FOV: 45 degrees. Color fundus image. 1380x1382px
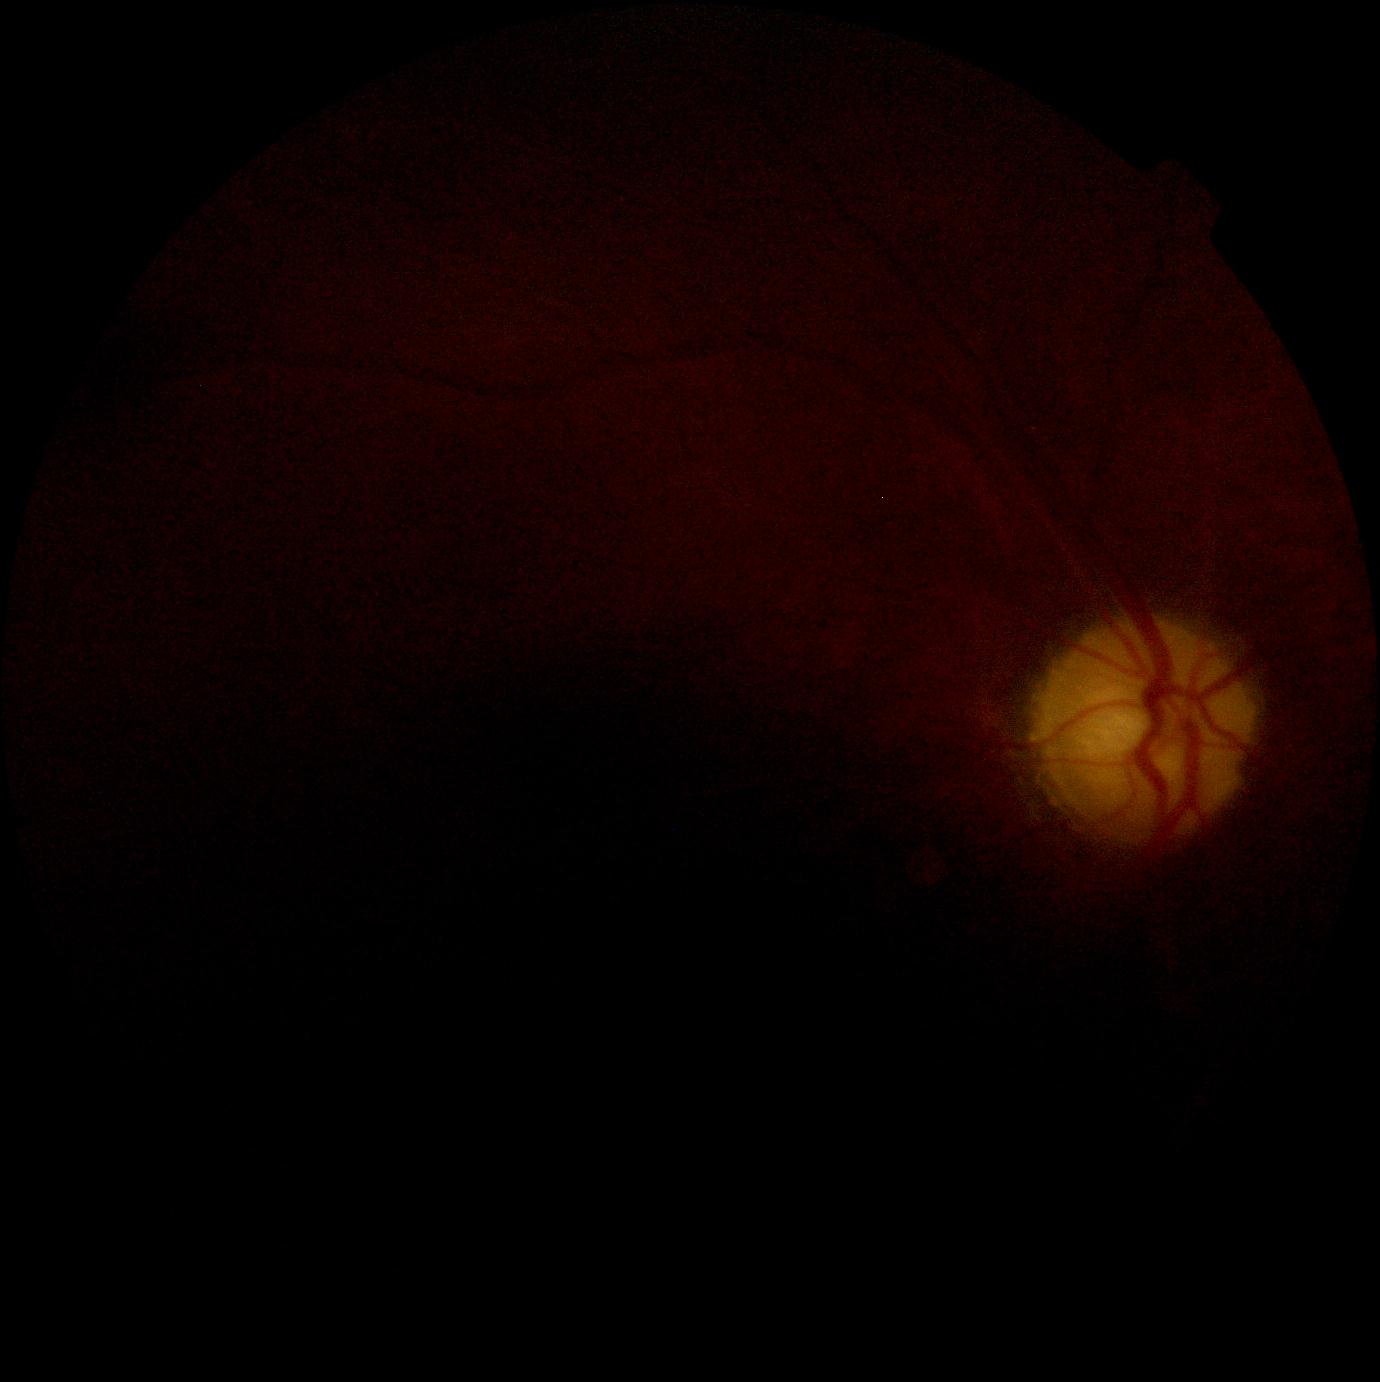 DR severity is ungradable.